848 by 848 pixels, without pupil dilation: 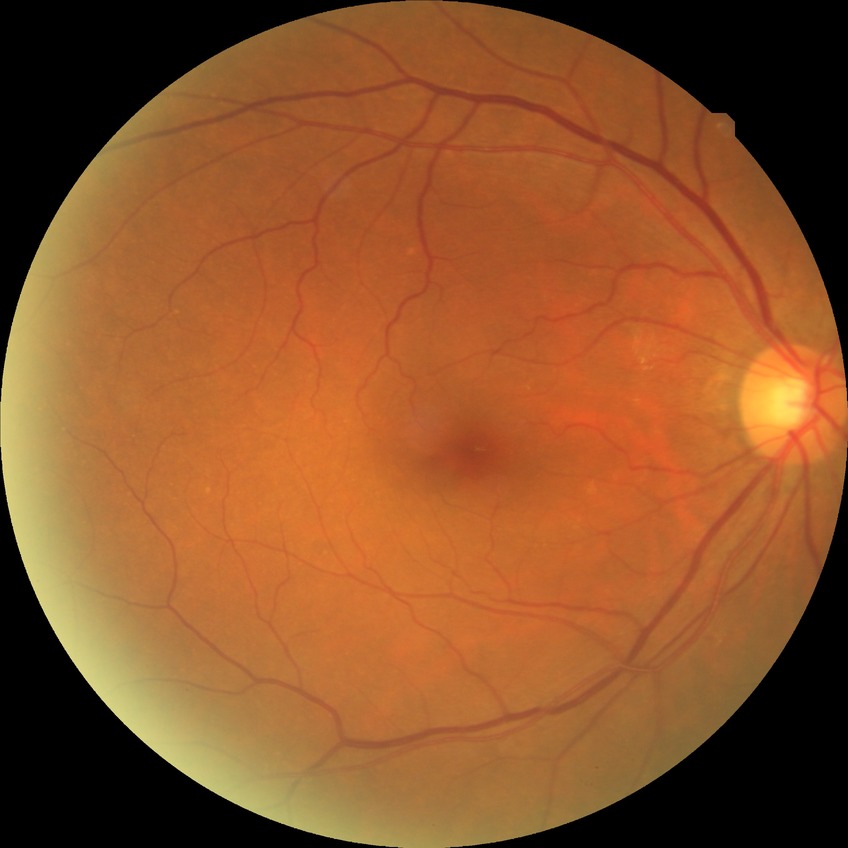

{"davis_grade": "NDR (no diabetic retinopathy)"}